1240 by 1240 pixels · wide-field contact fundus photograph of an infant · captured with the Phoenix ICON (100° field of view).
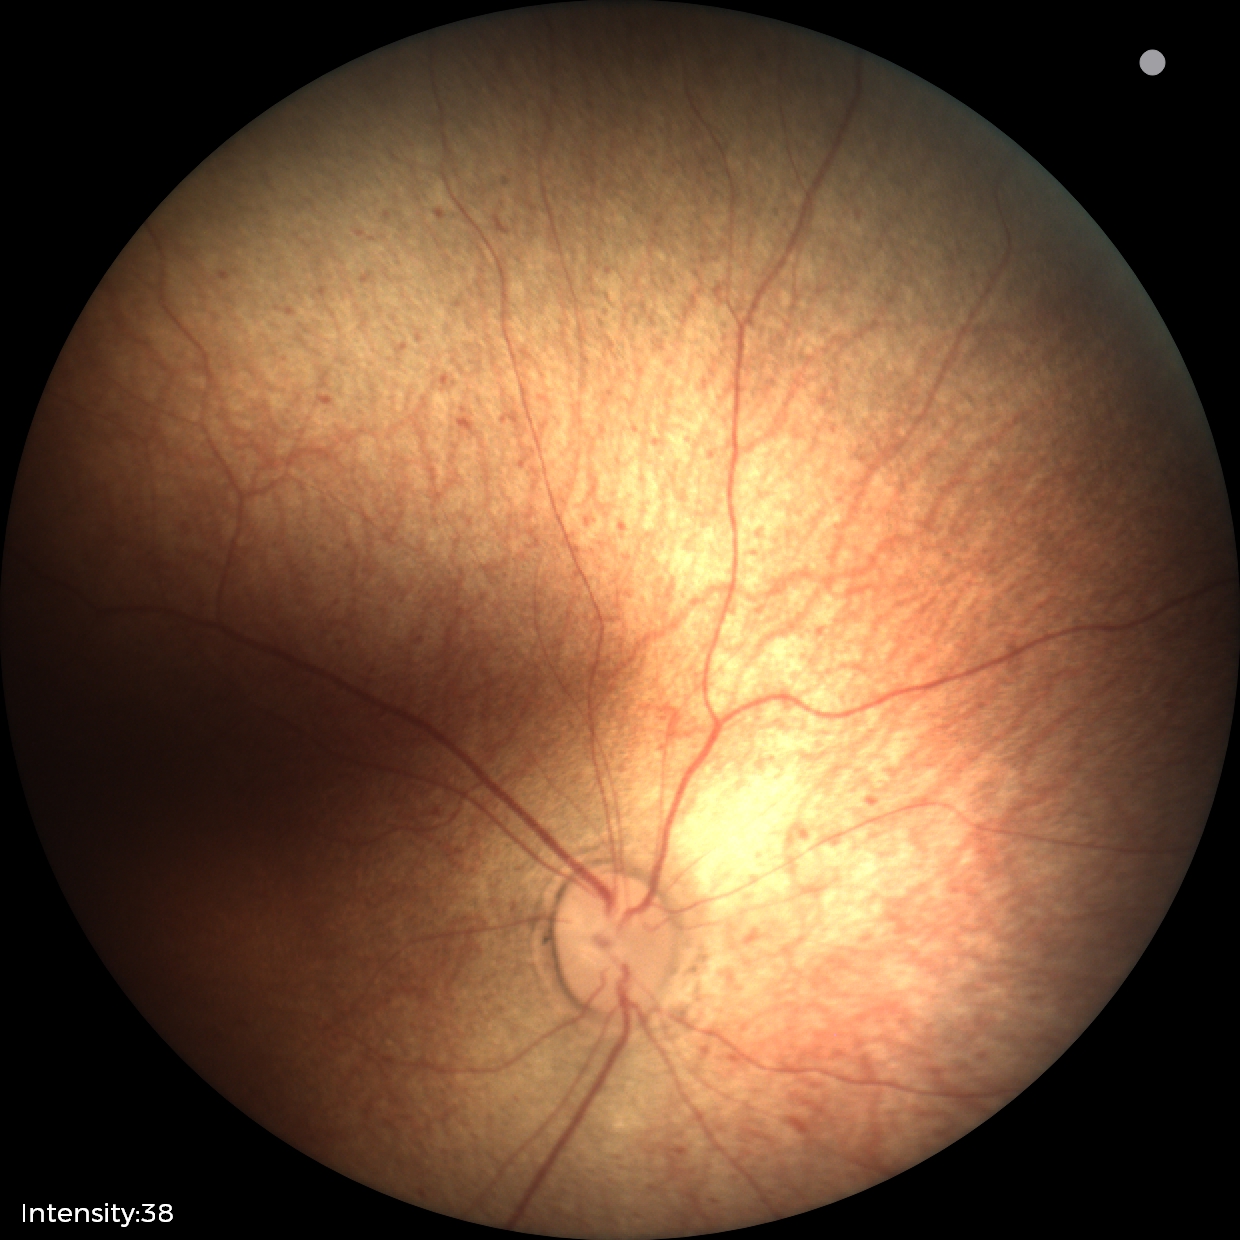

Normal screening examination.